Infant wide-field fundus photograph · 640 by 480 pixels · captured with the Clarity RetCam 3 (130° field of view) — 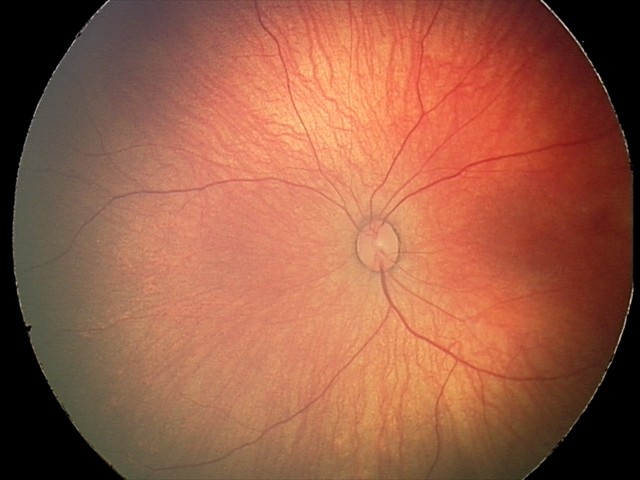 Diagnosis from this screening exam: retinal hemorrhages.